2212x1659. 45-degree field of view.
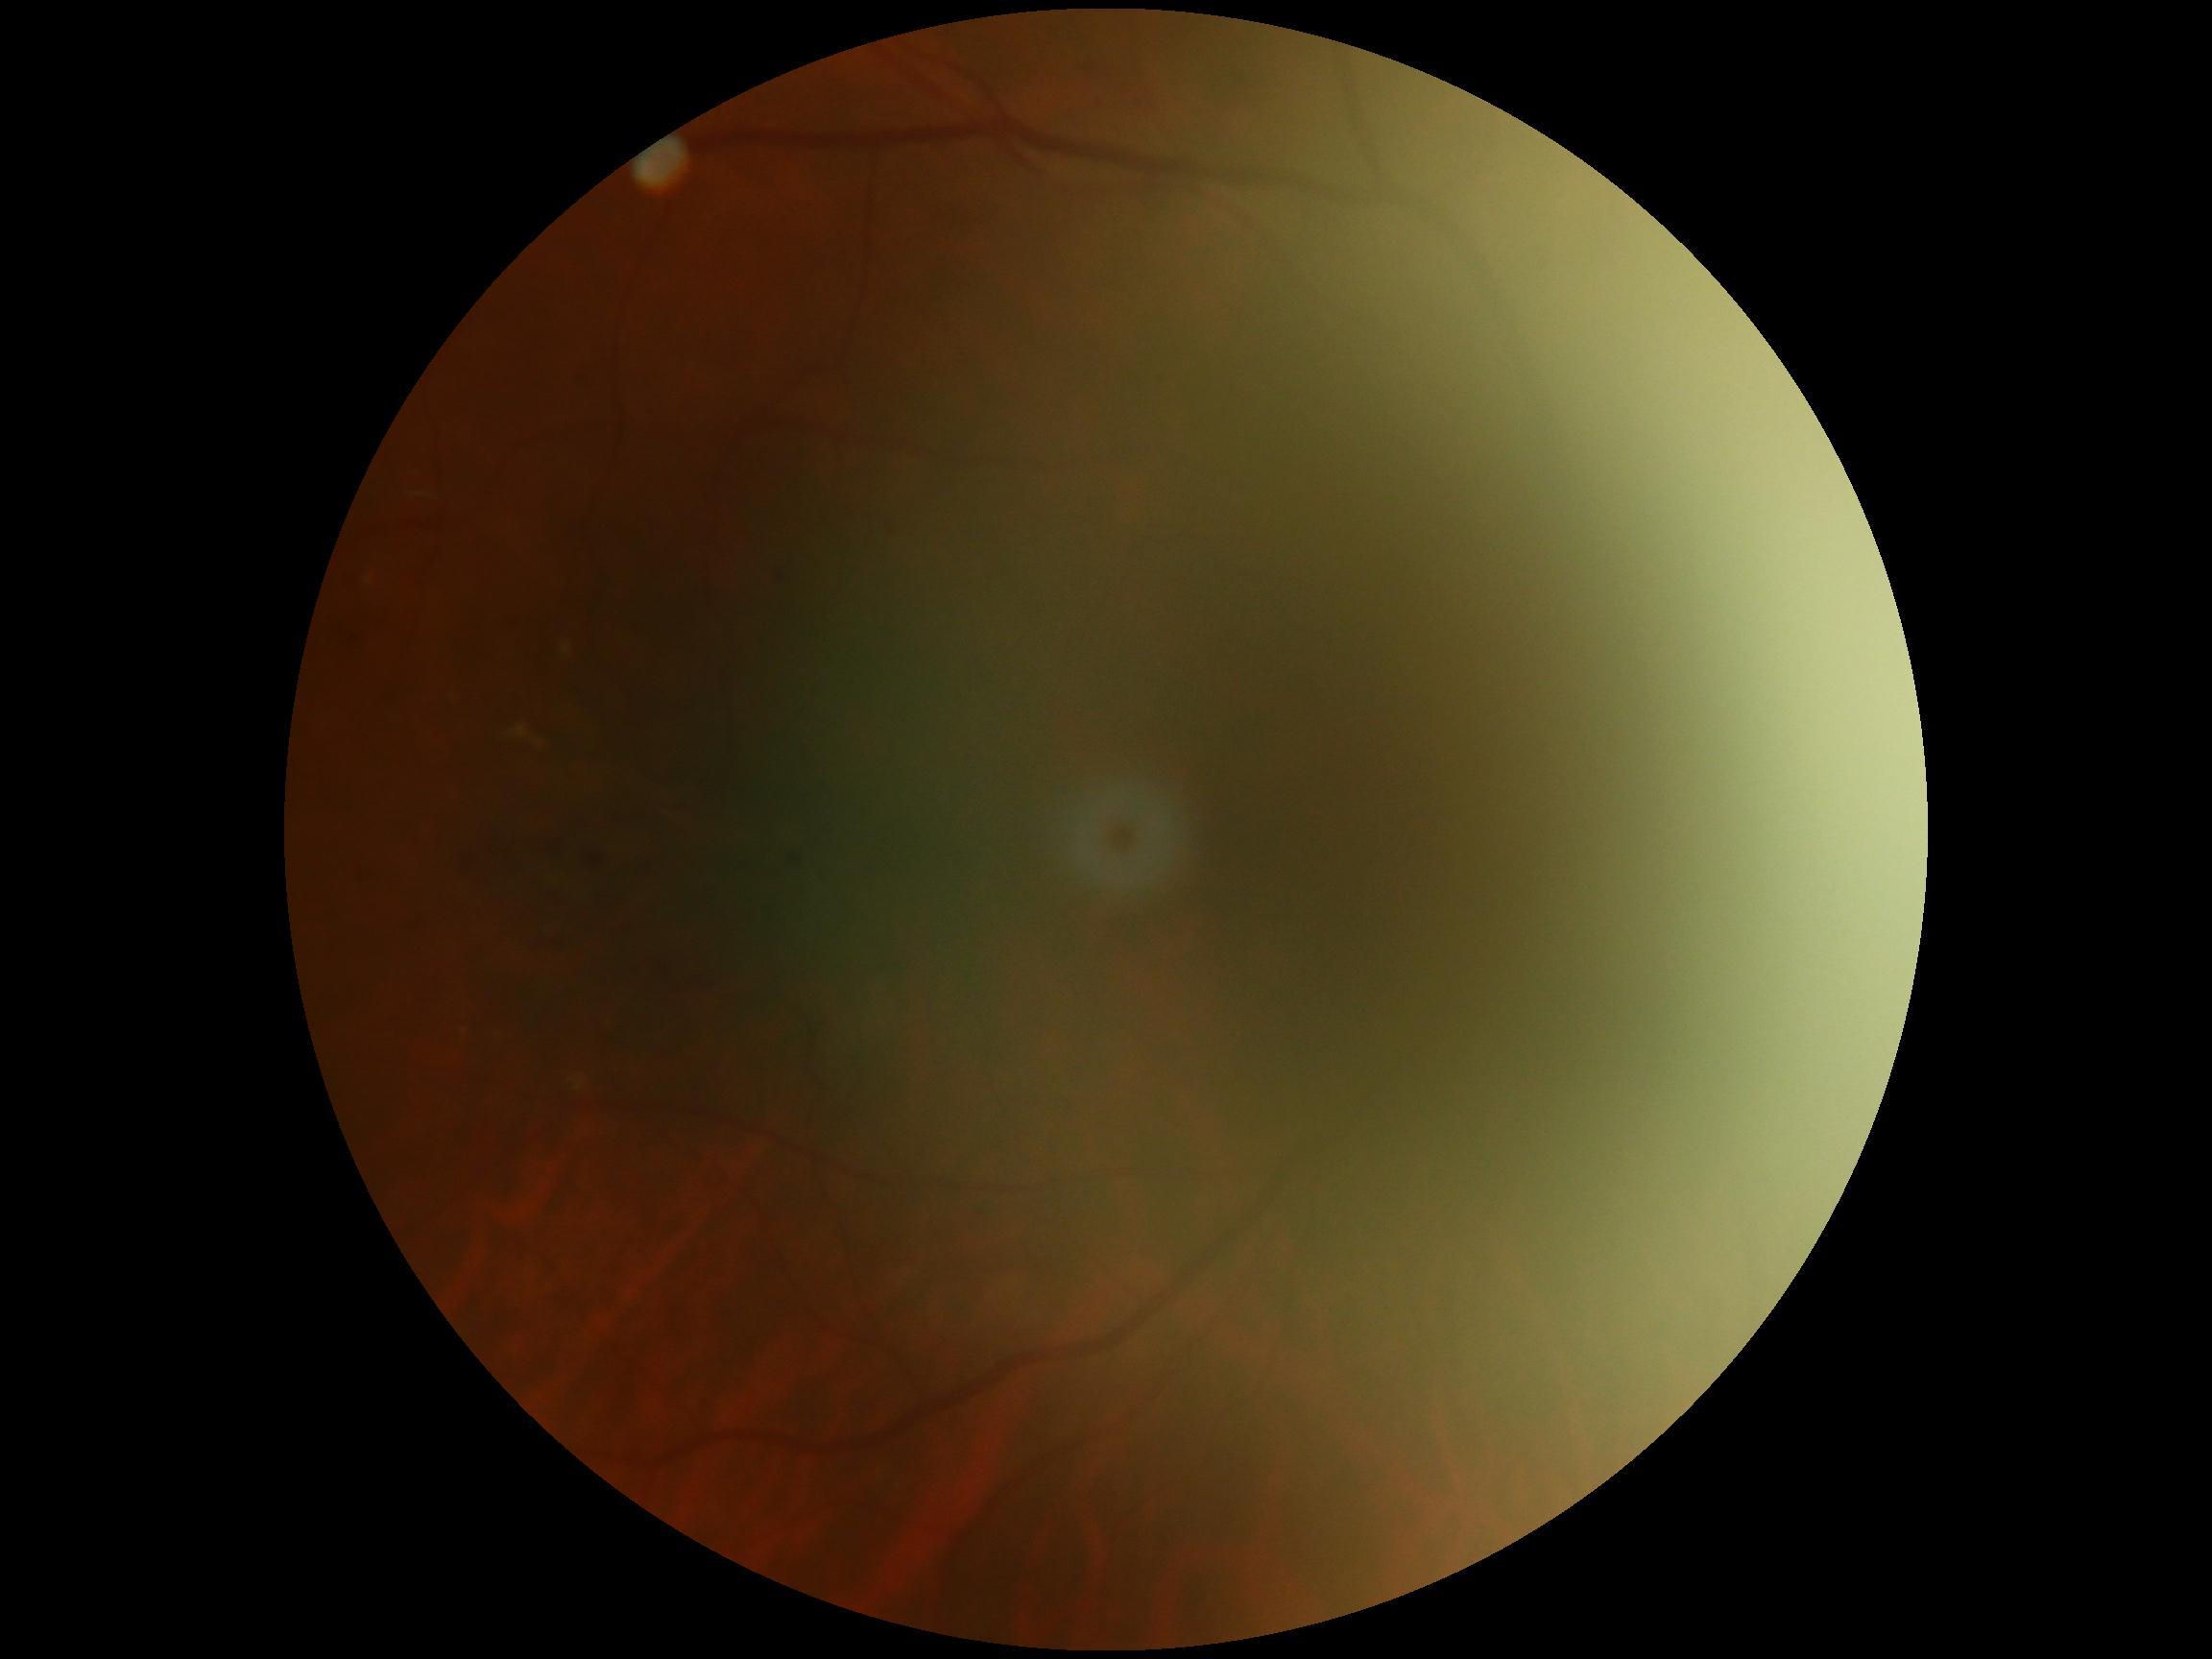
Diabetic retinopathy severity is ungradable due to poor image quality.